Disc-centered field. Fundus photo. Acquired with a Nidek AFC-330 — 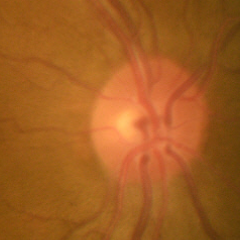
Glaucoma diagnosis: no glaucomatous changes.